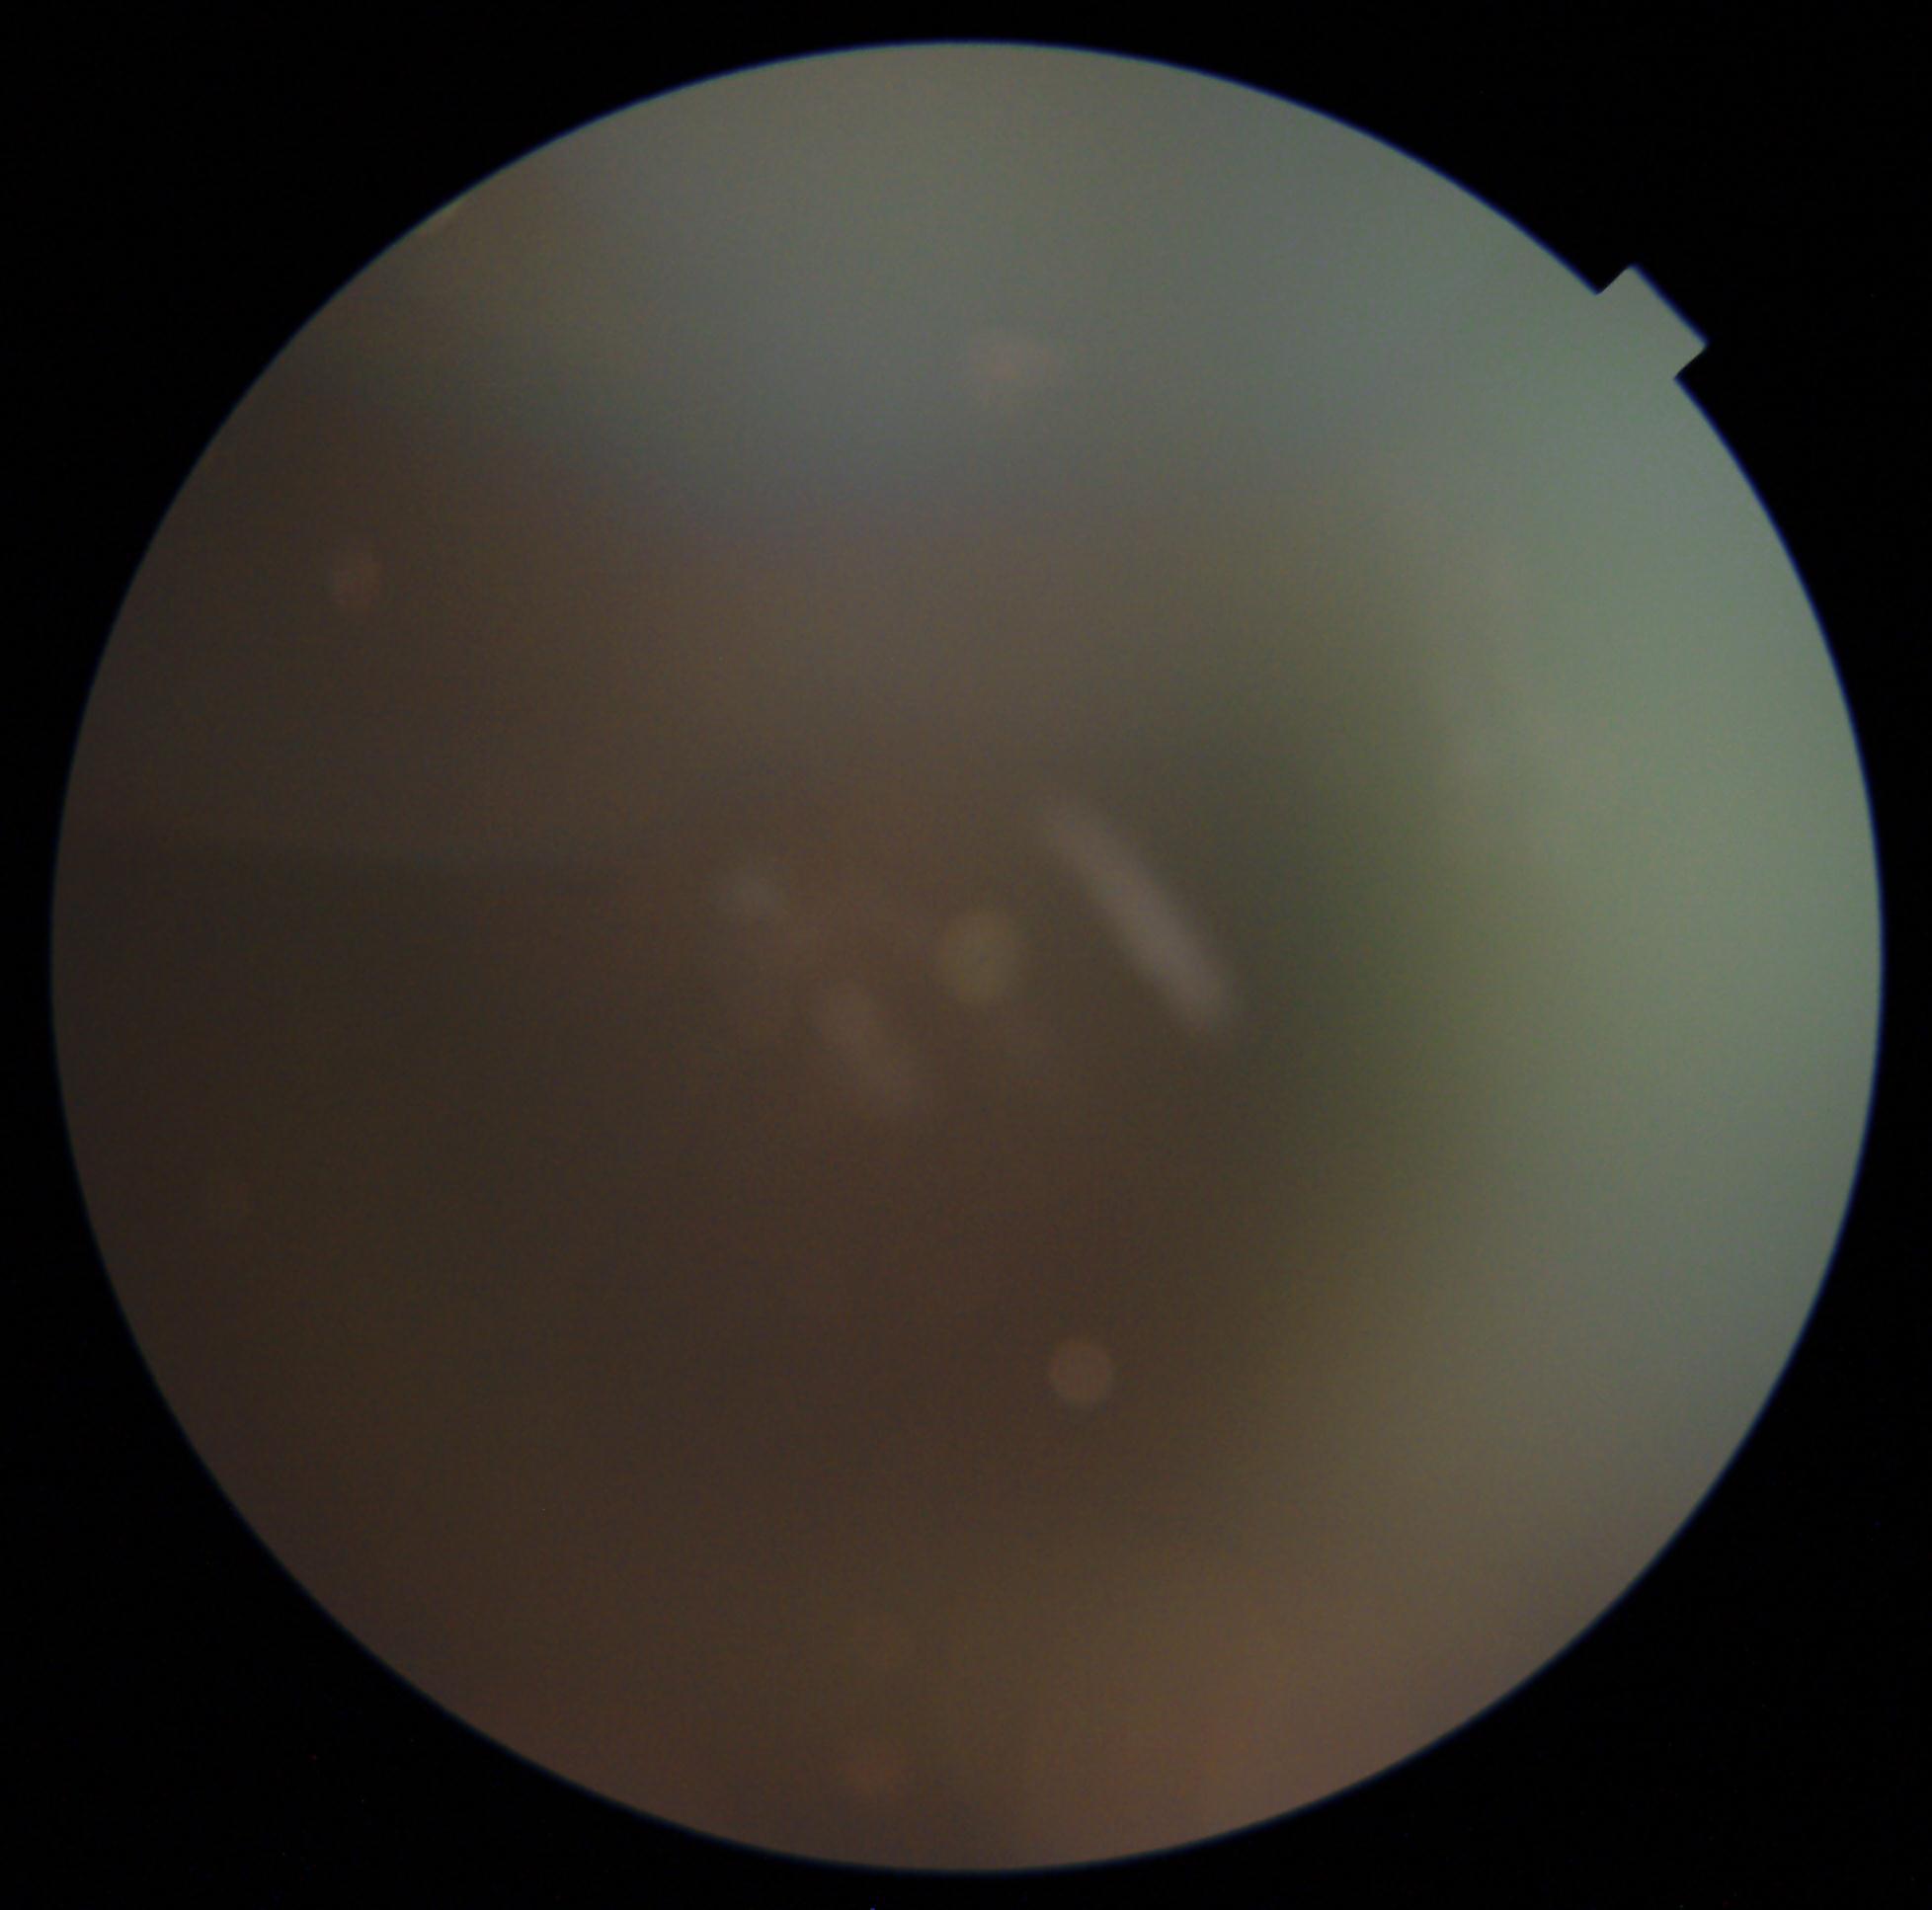

  dr_grade: ungradable due to poor image quality